Ultra-widefield fundus mosaic:
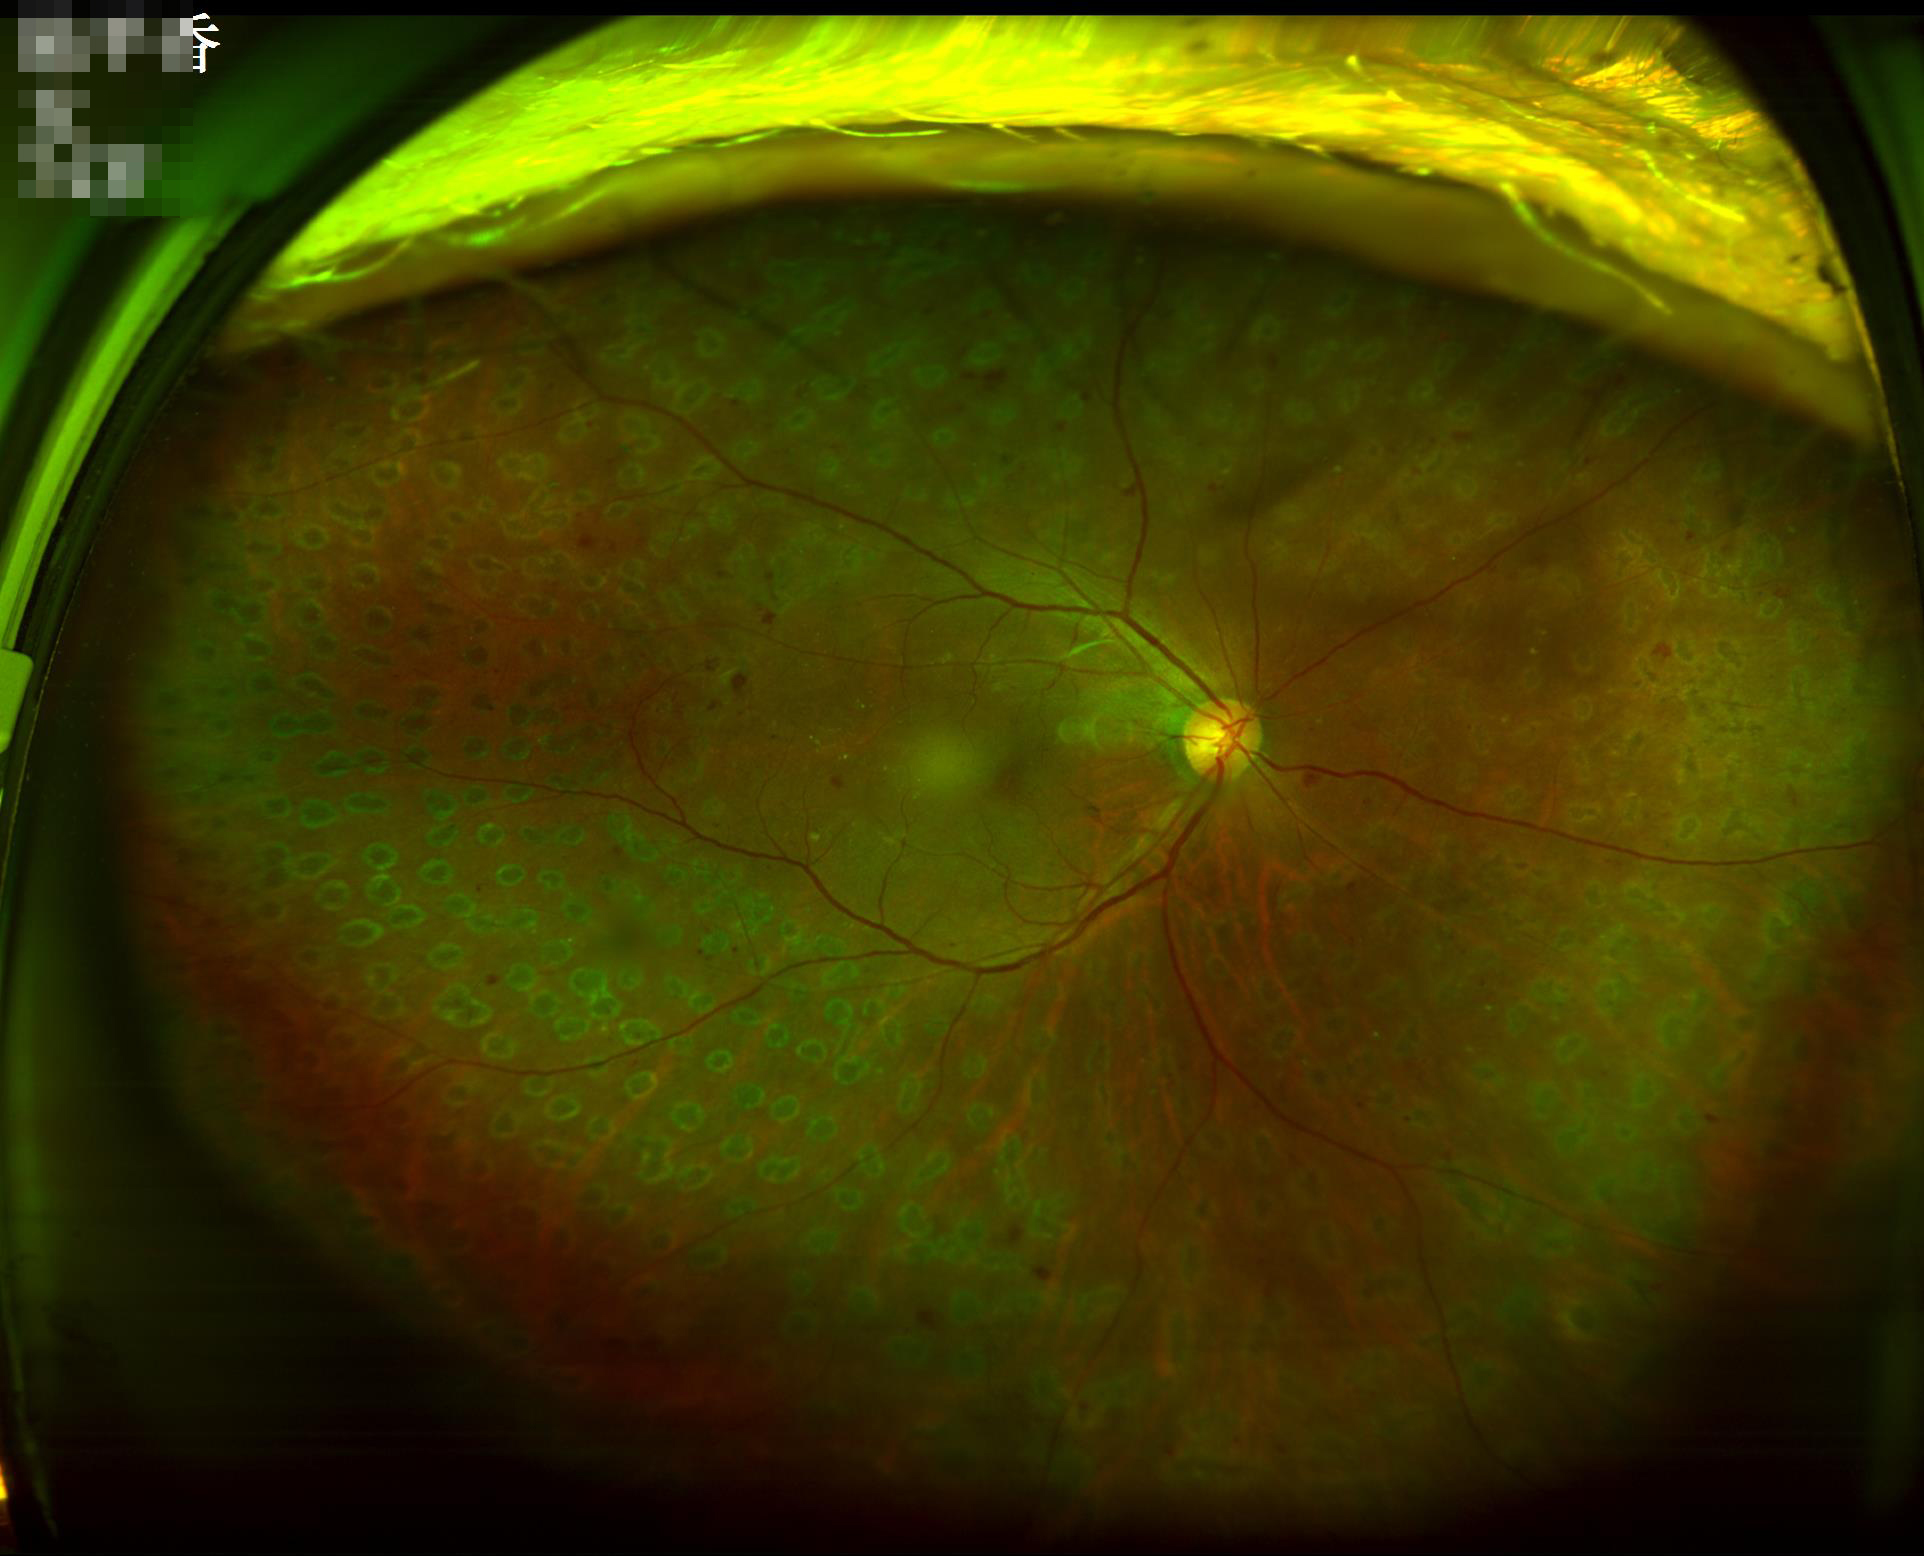
Illumination/color = good illumination and color balance
Overall quality = good, gradable